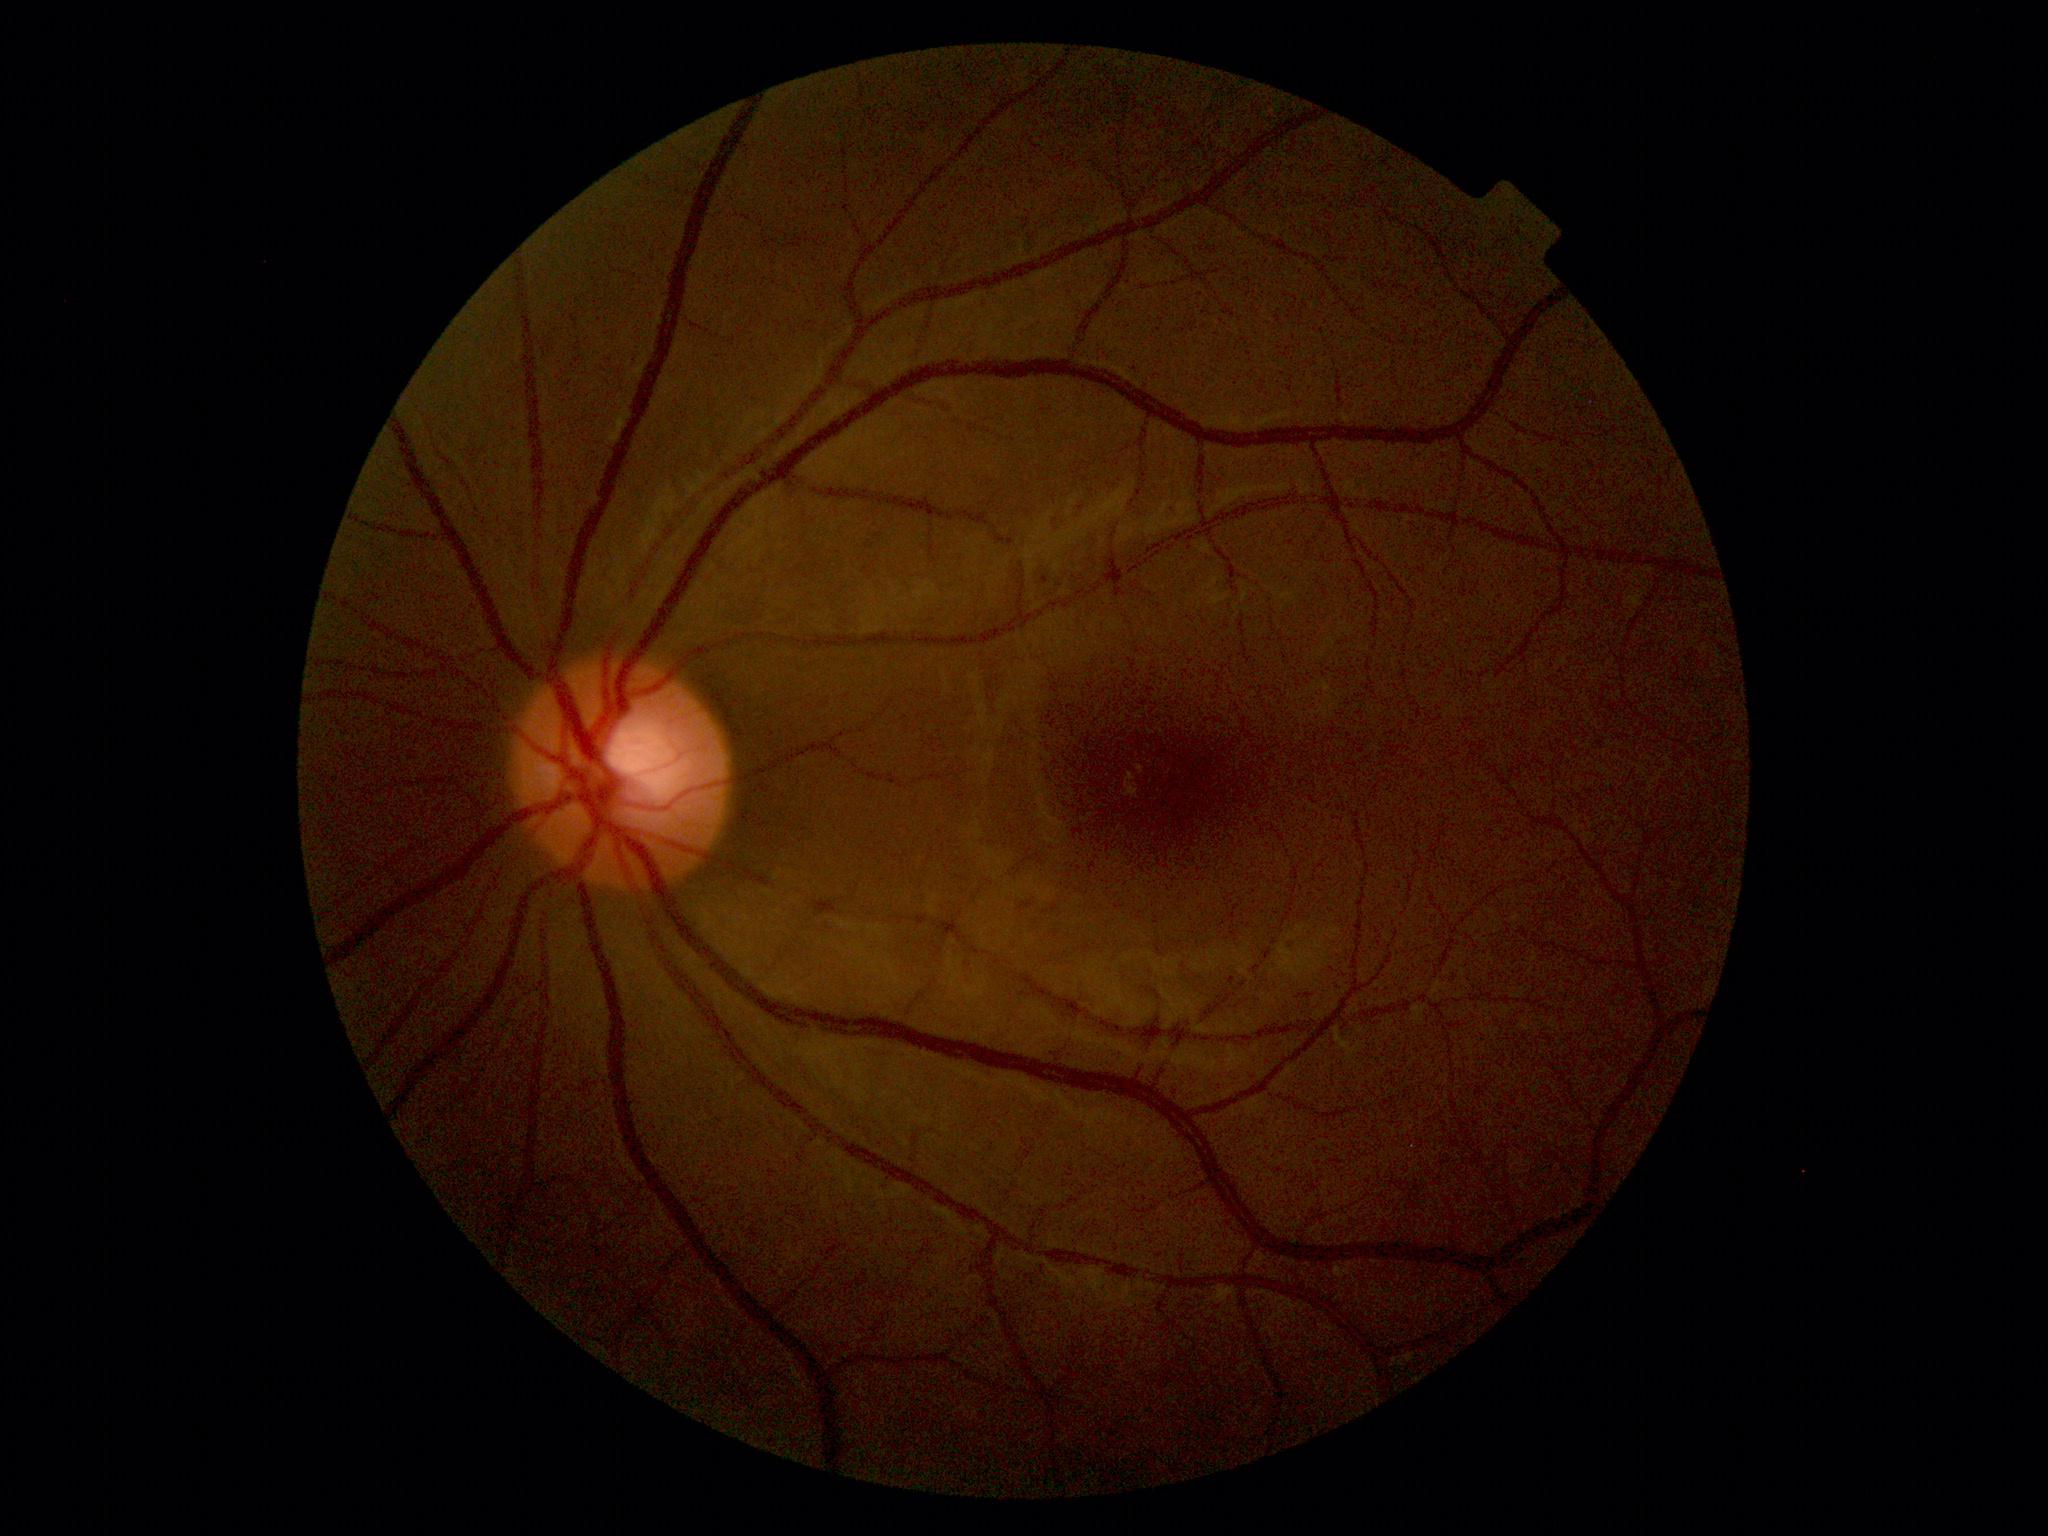
dr_grade: mild NPDR (grade 1)
dr_category: non-proliferative diabetic retinopathy